2048x1536; color fundus photograph.
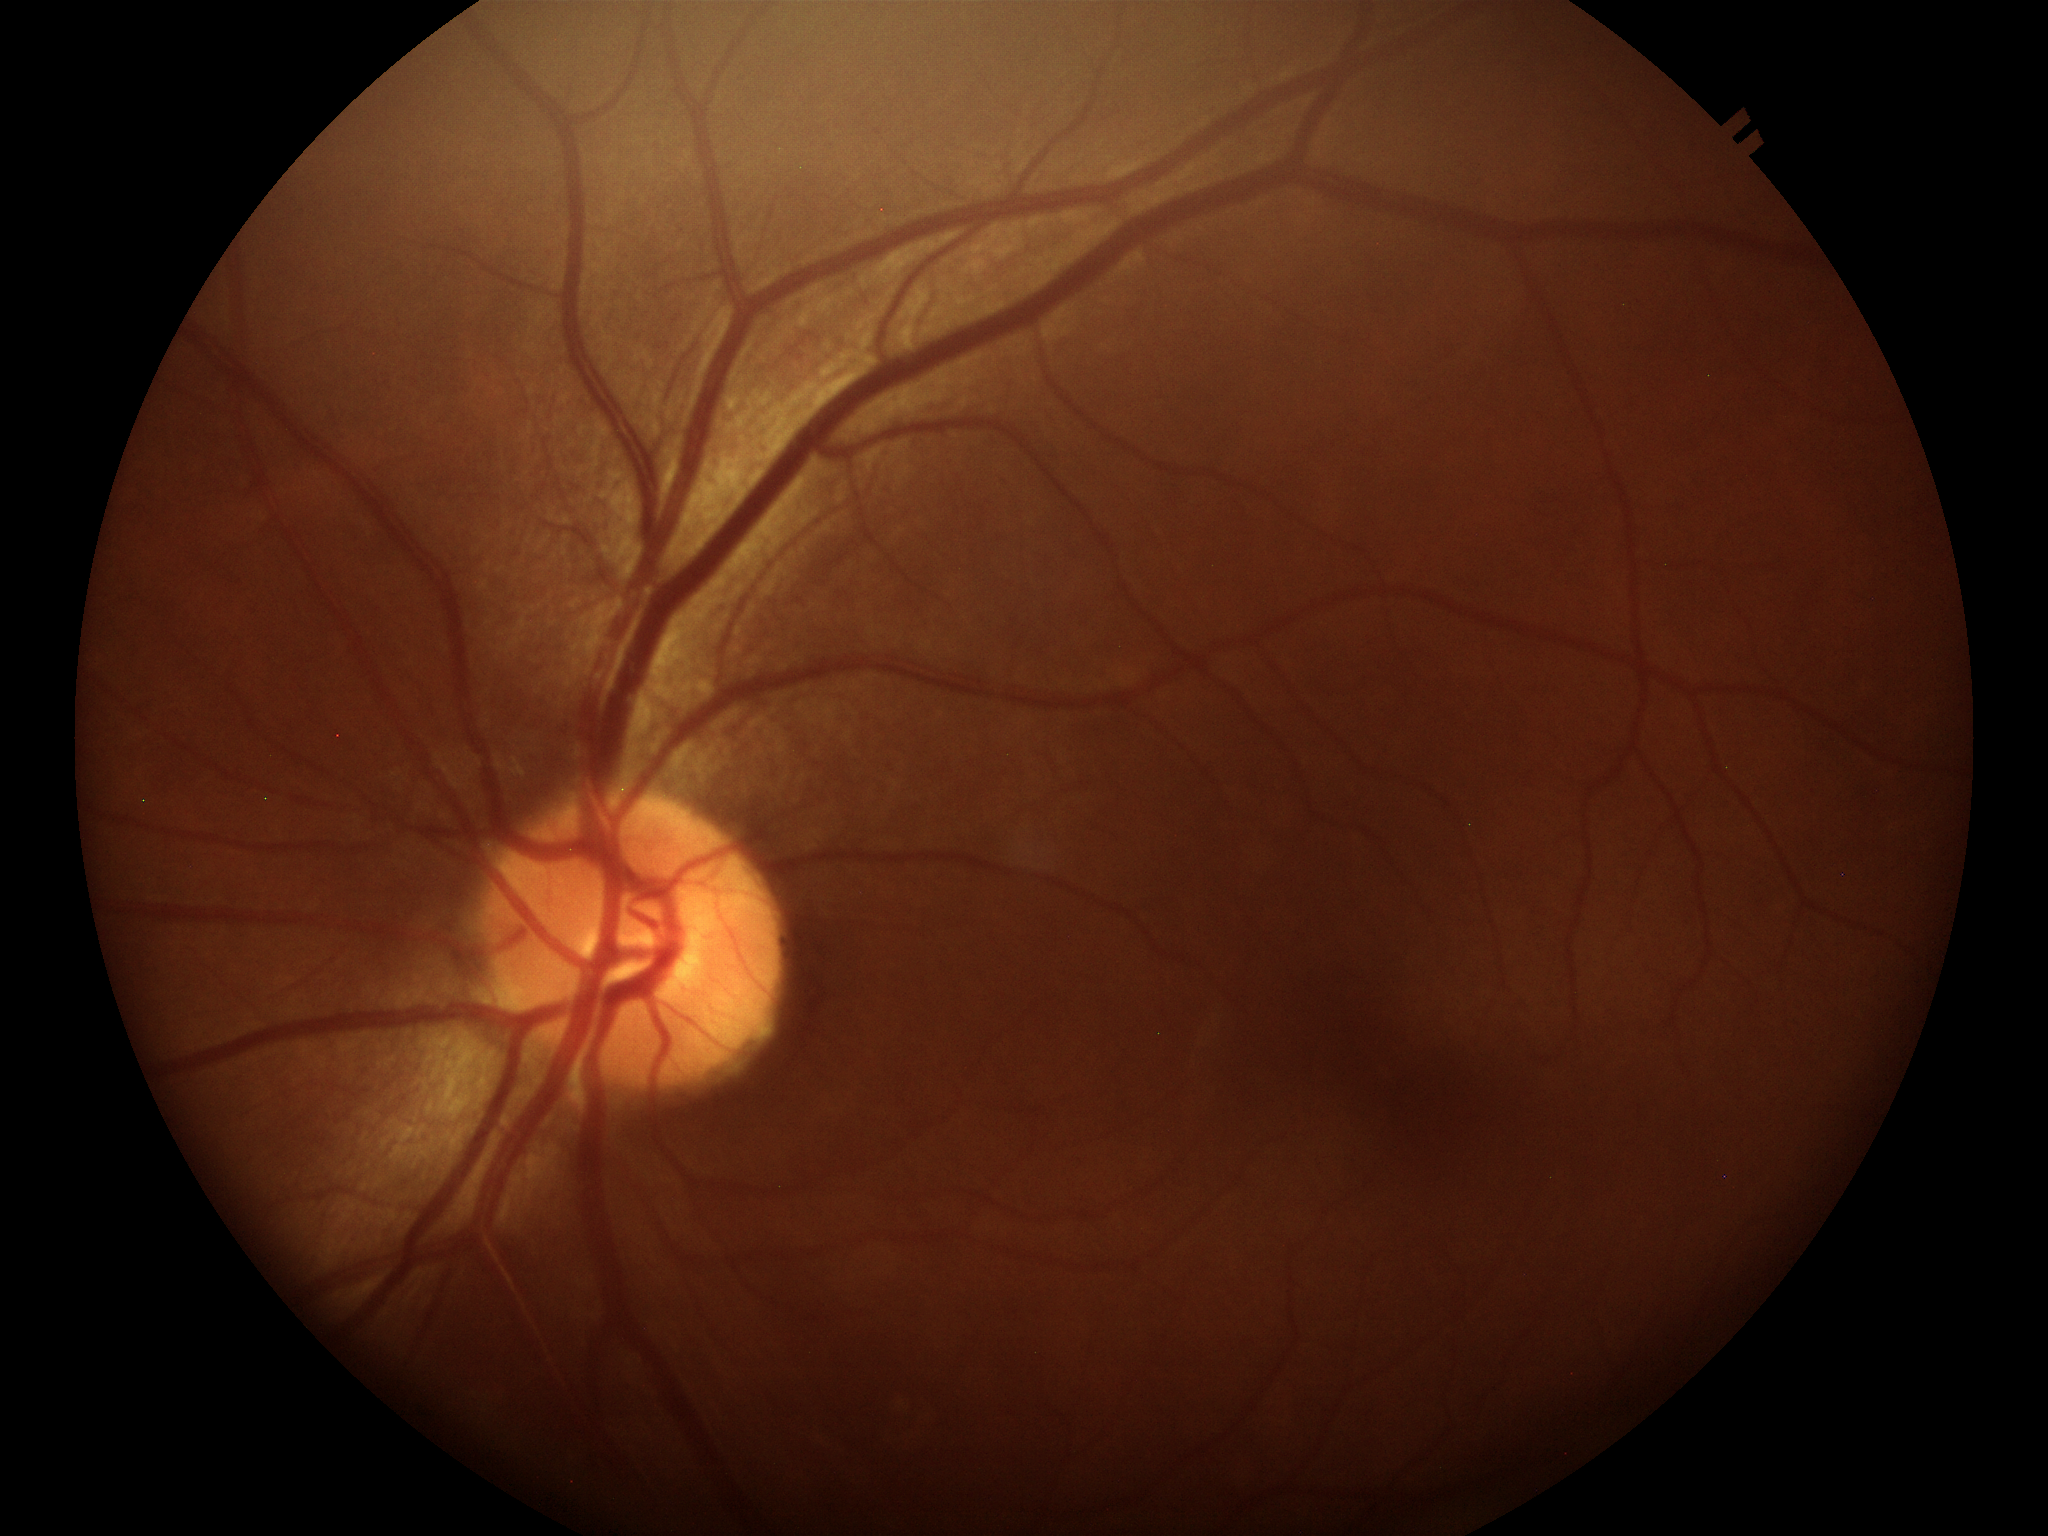
Glaucoma screening: negative.
Vertical cup-to-disc ratio is 0.43.